Camera: Clarity RetCam 3 (130° FOV); wide-field fundus photograph from neonatal ROP screening — 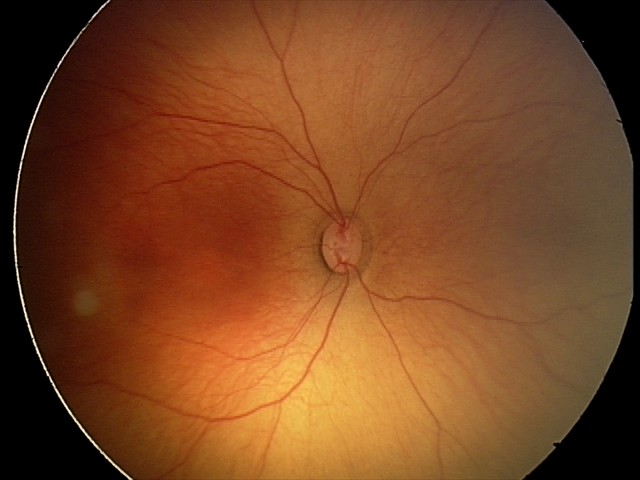
Screening: no abnormal retinal findings.